2352 by 1568 pixels:
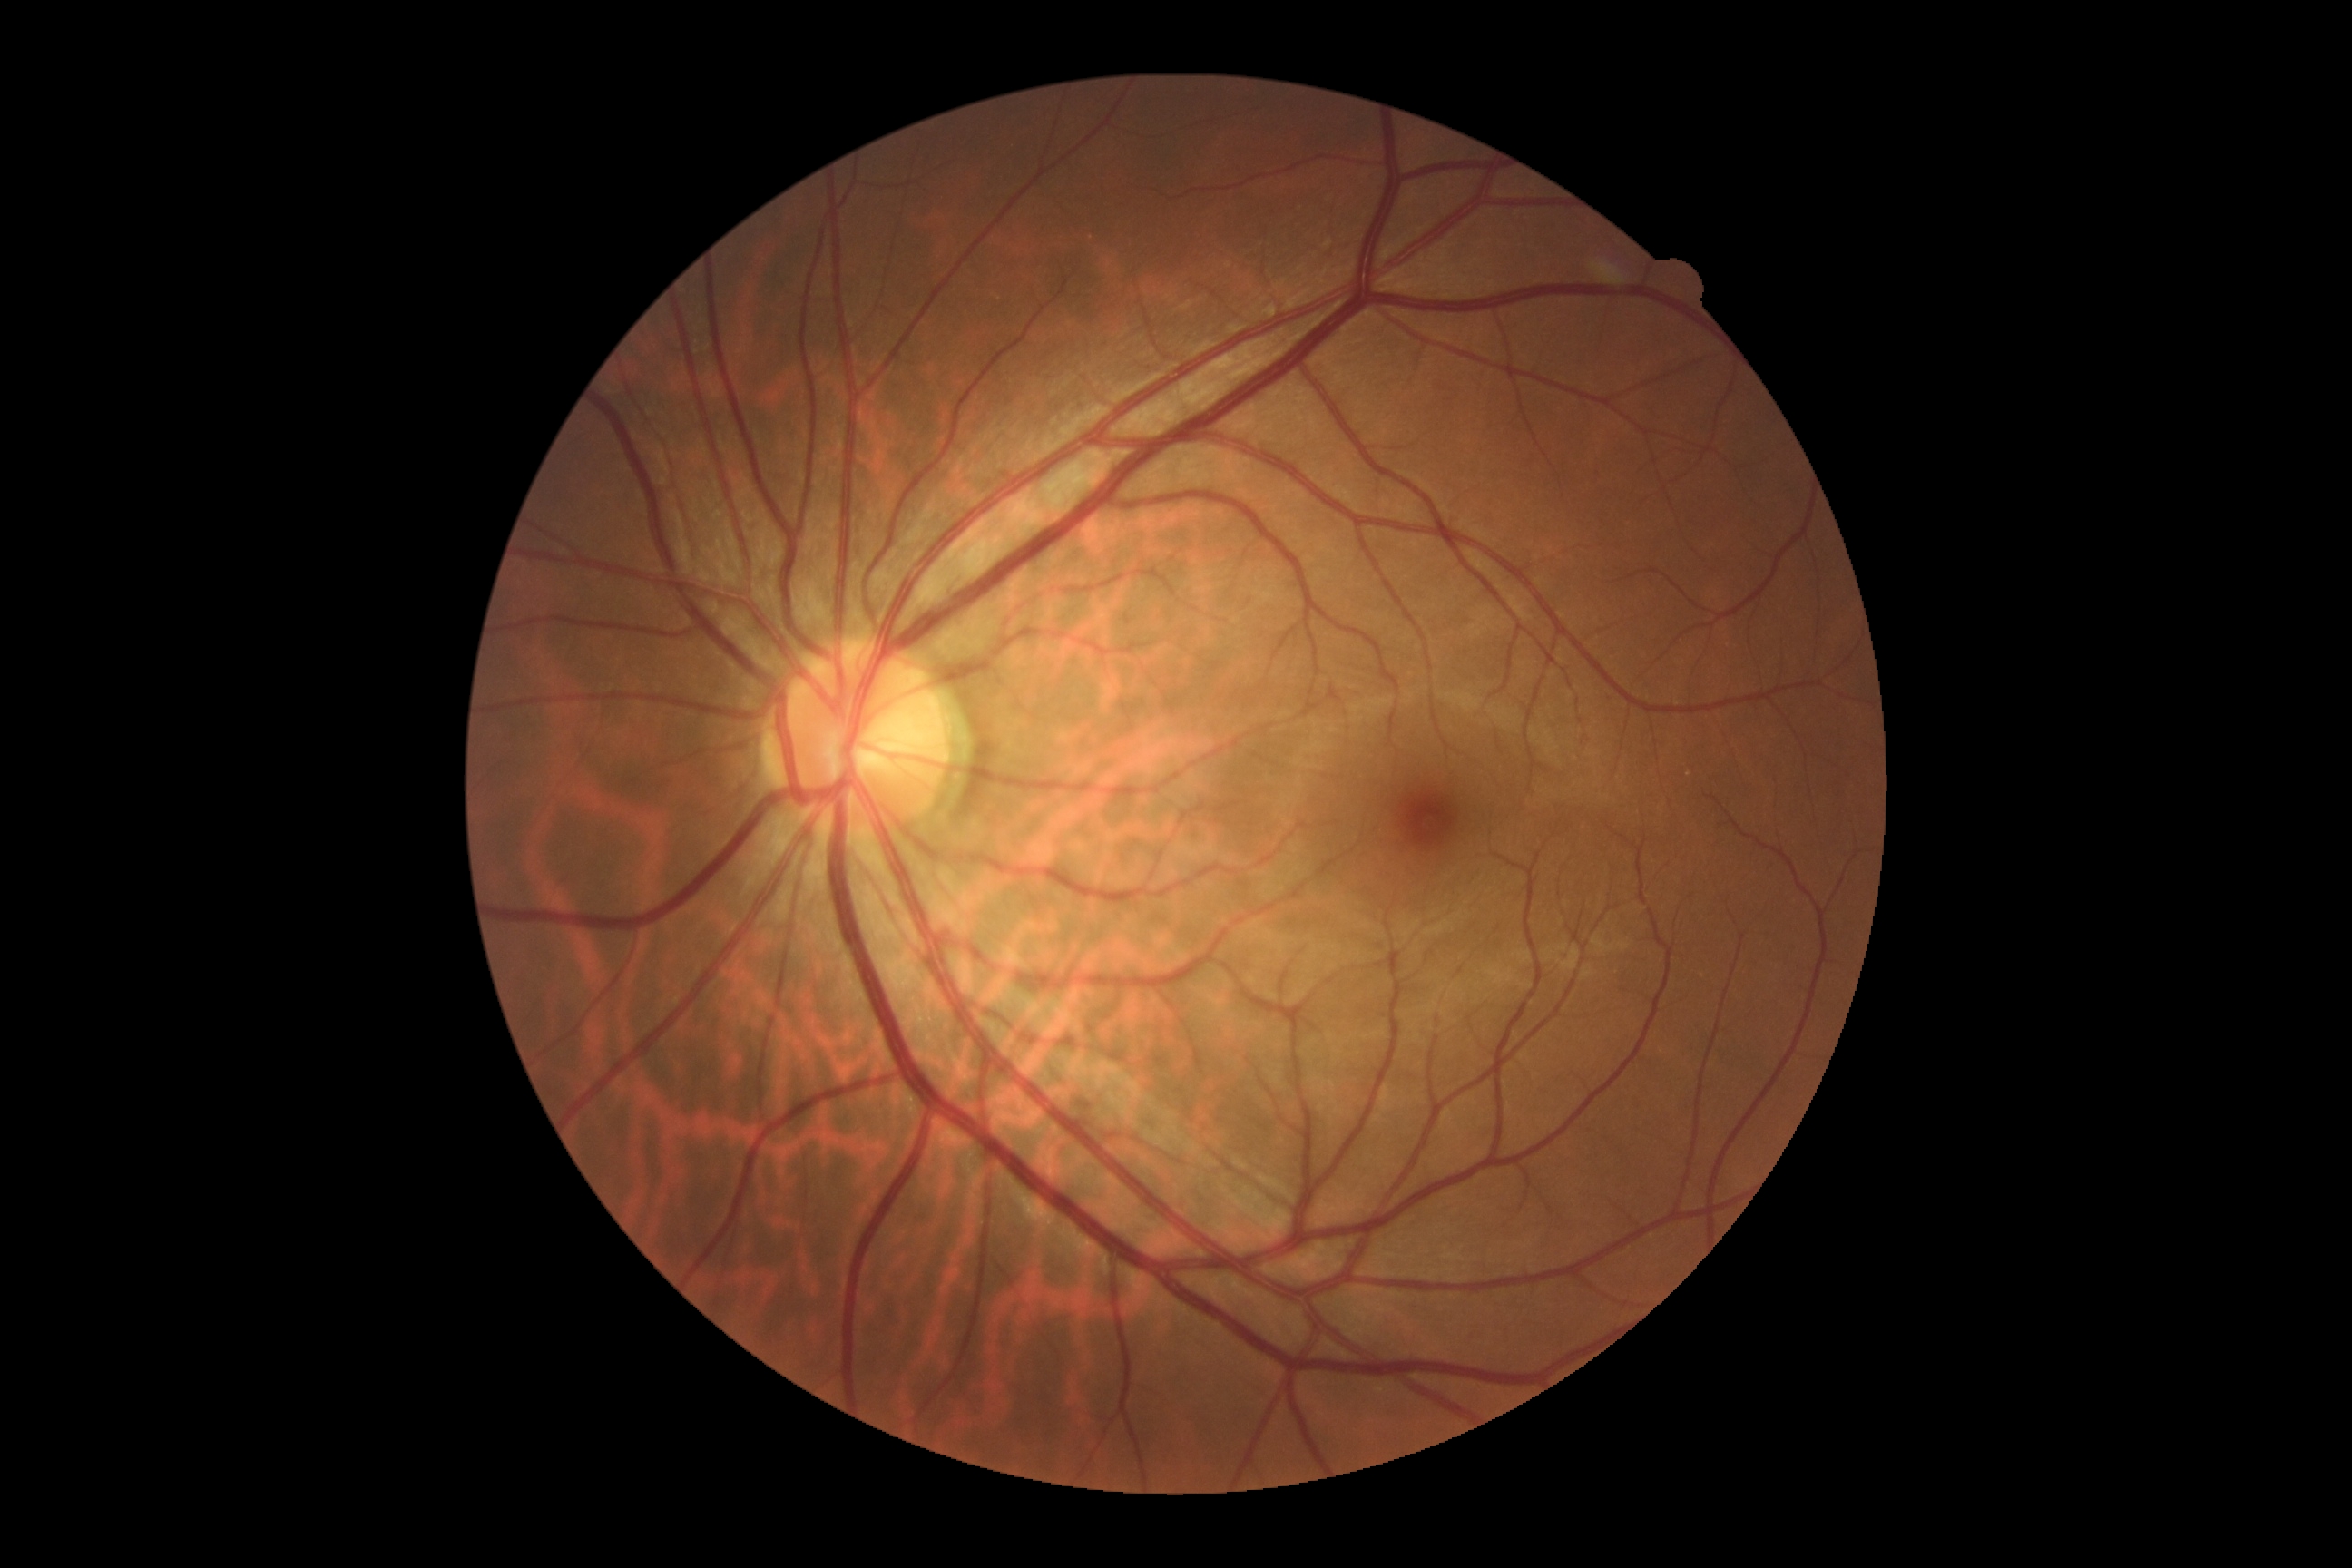

- diabetic retinopathy severity: 0/4
- DR impression: no DR findings